Modified Davis grading: 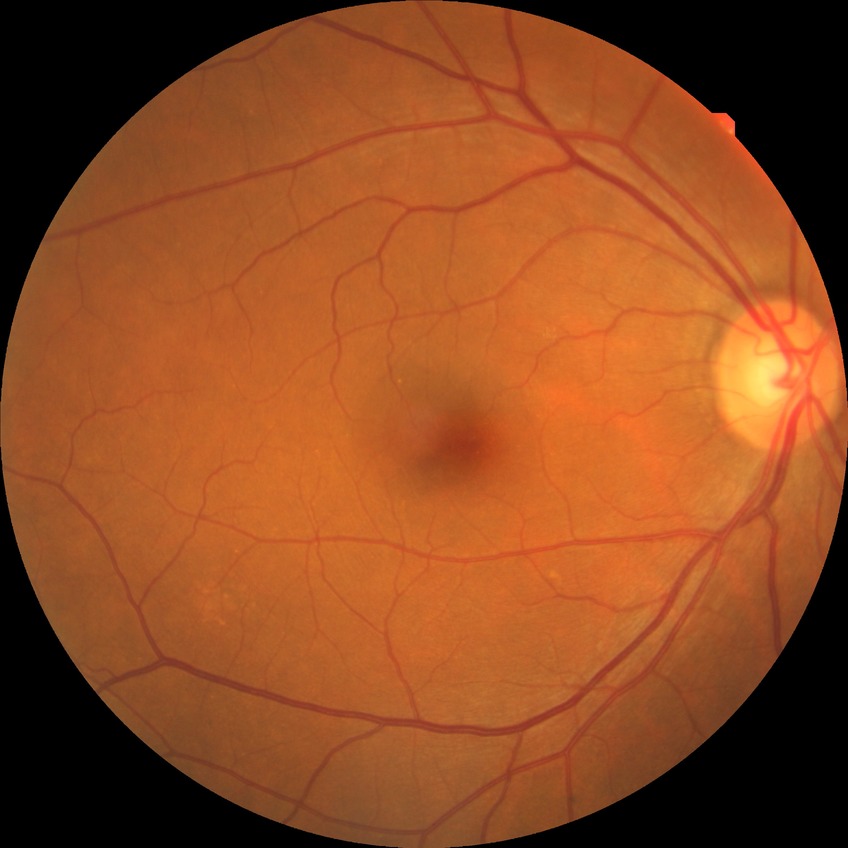
davis_grade: no diabetic retinopathy